Acquired with a Nidek AFC-330, non-mydriatic — 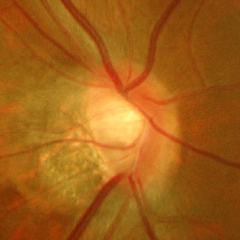 Glaucoma status: advanced glaucoma.